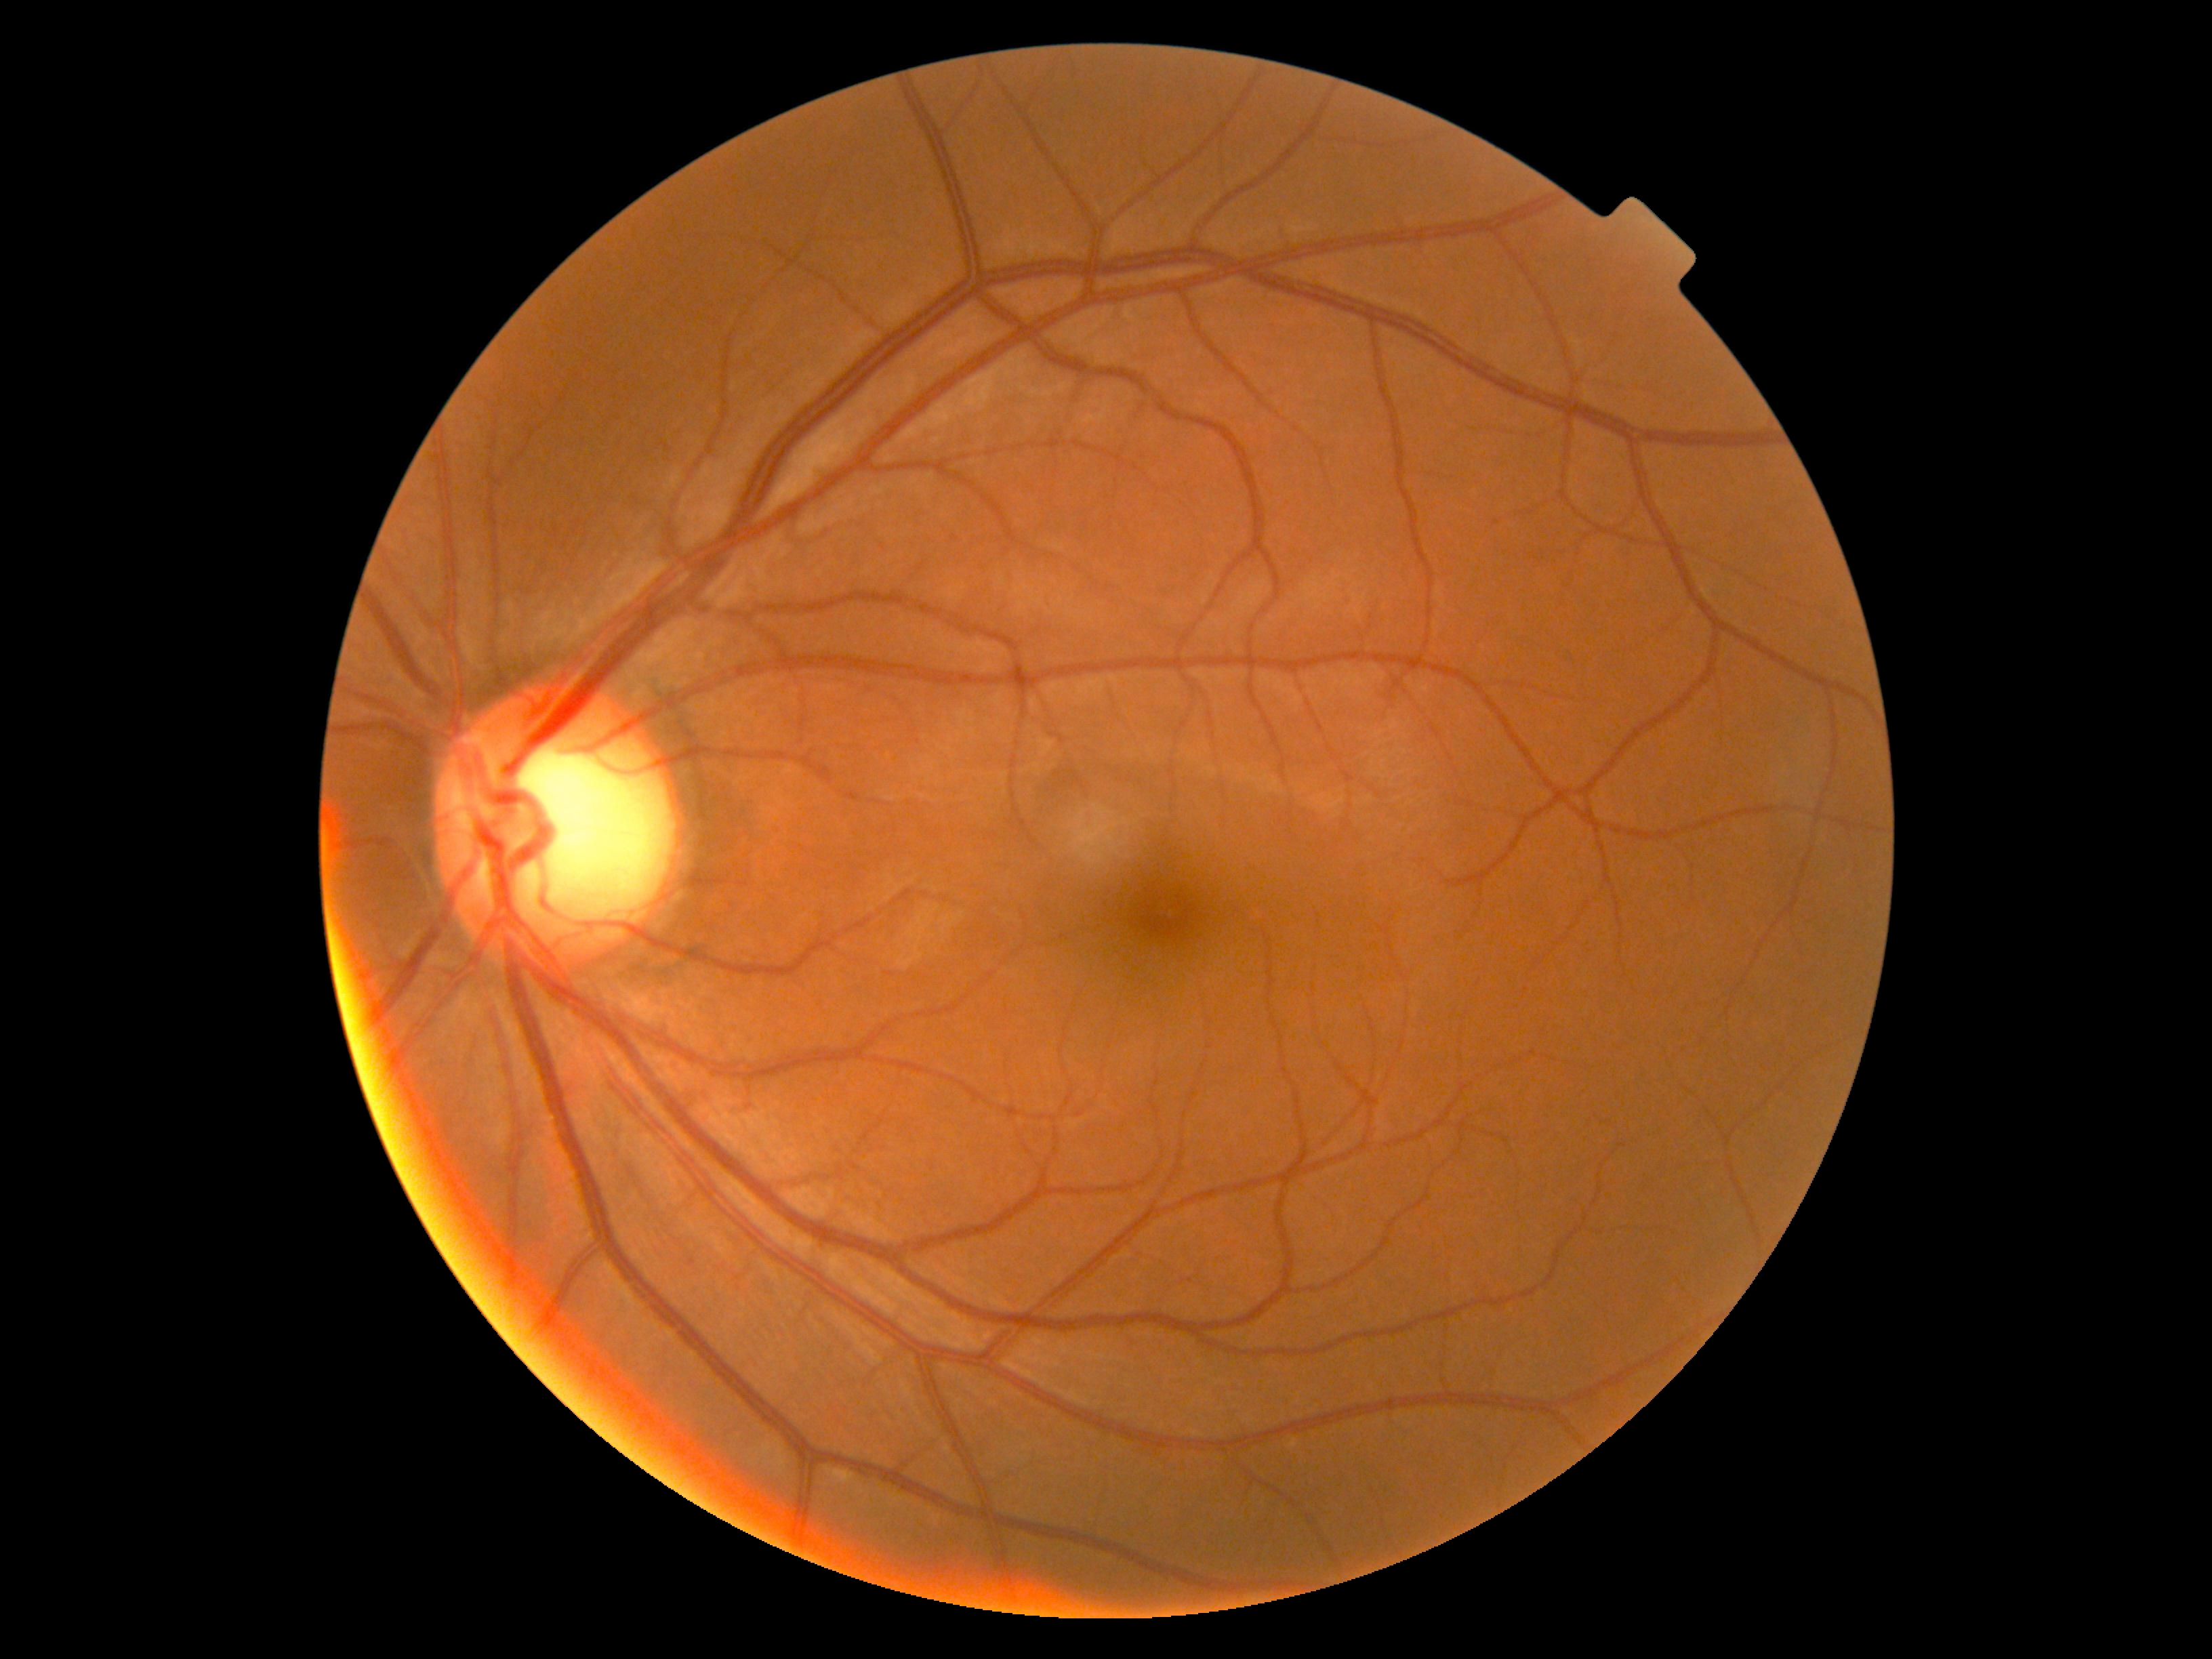

DR grade is 0. No diabetic retinal disease findings.